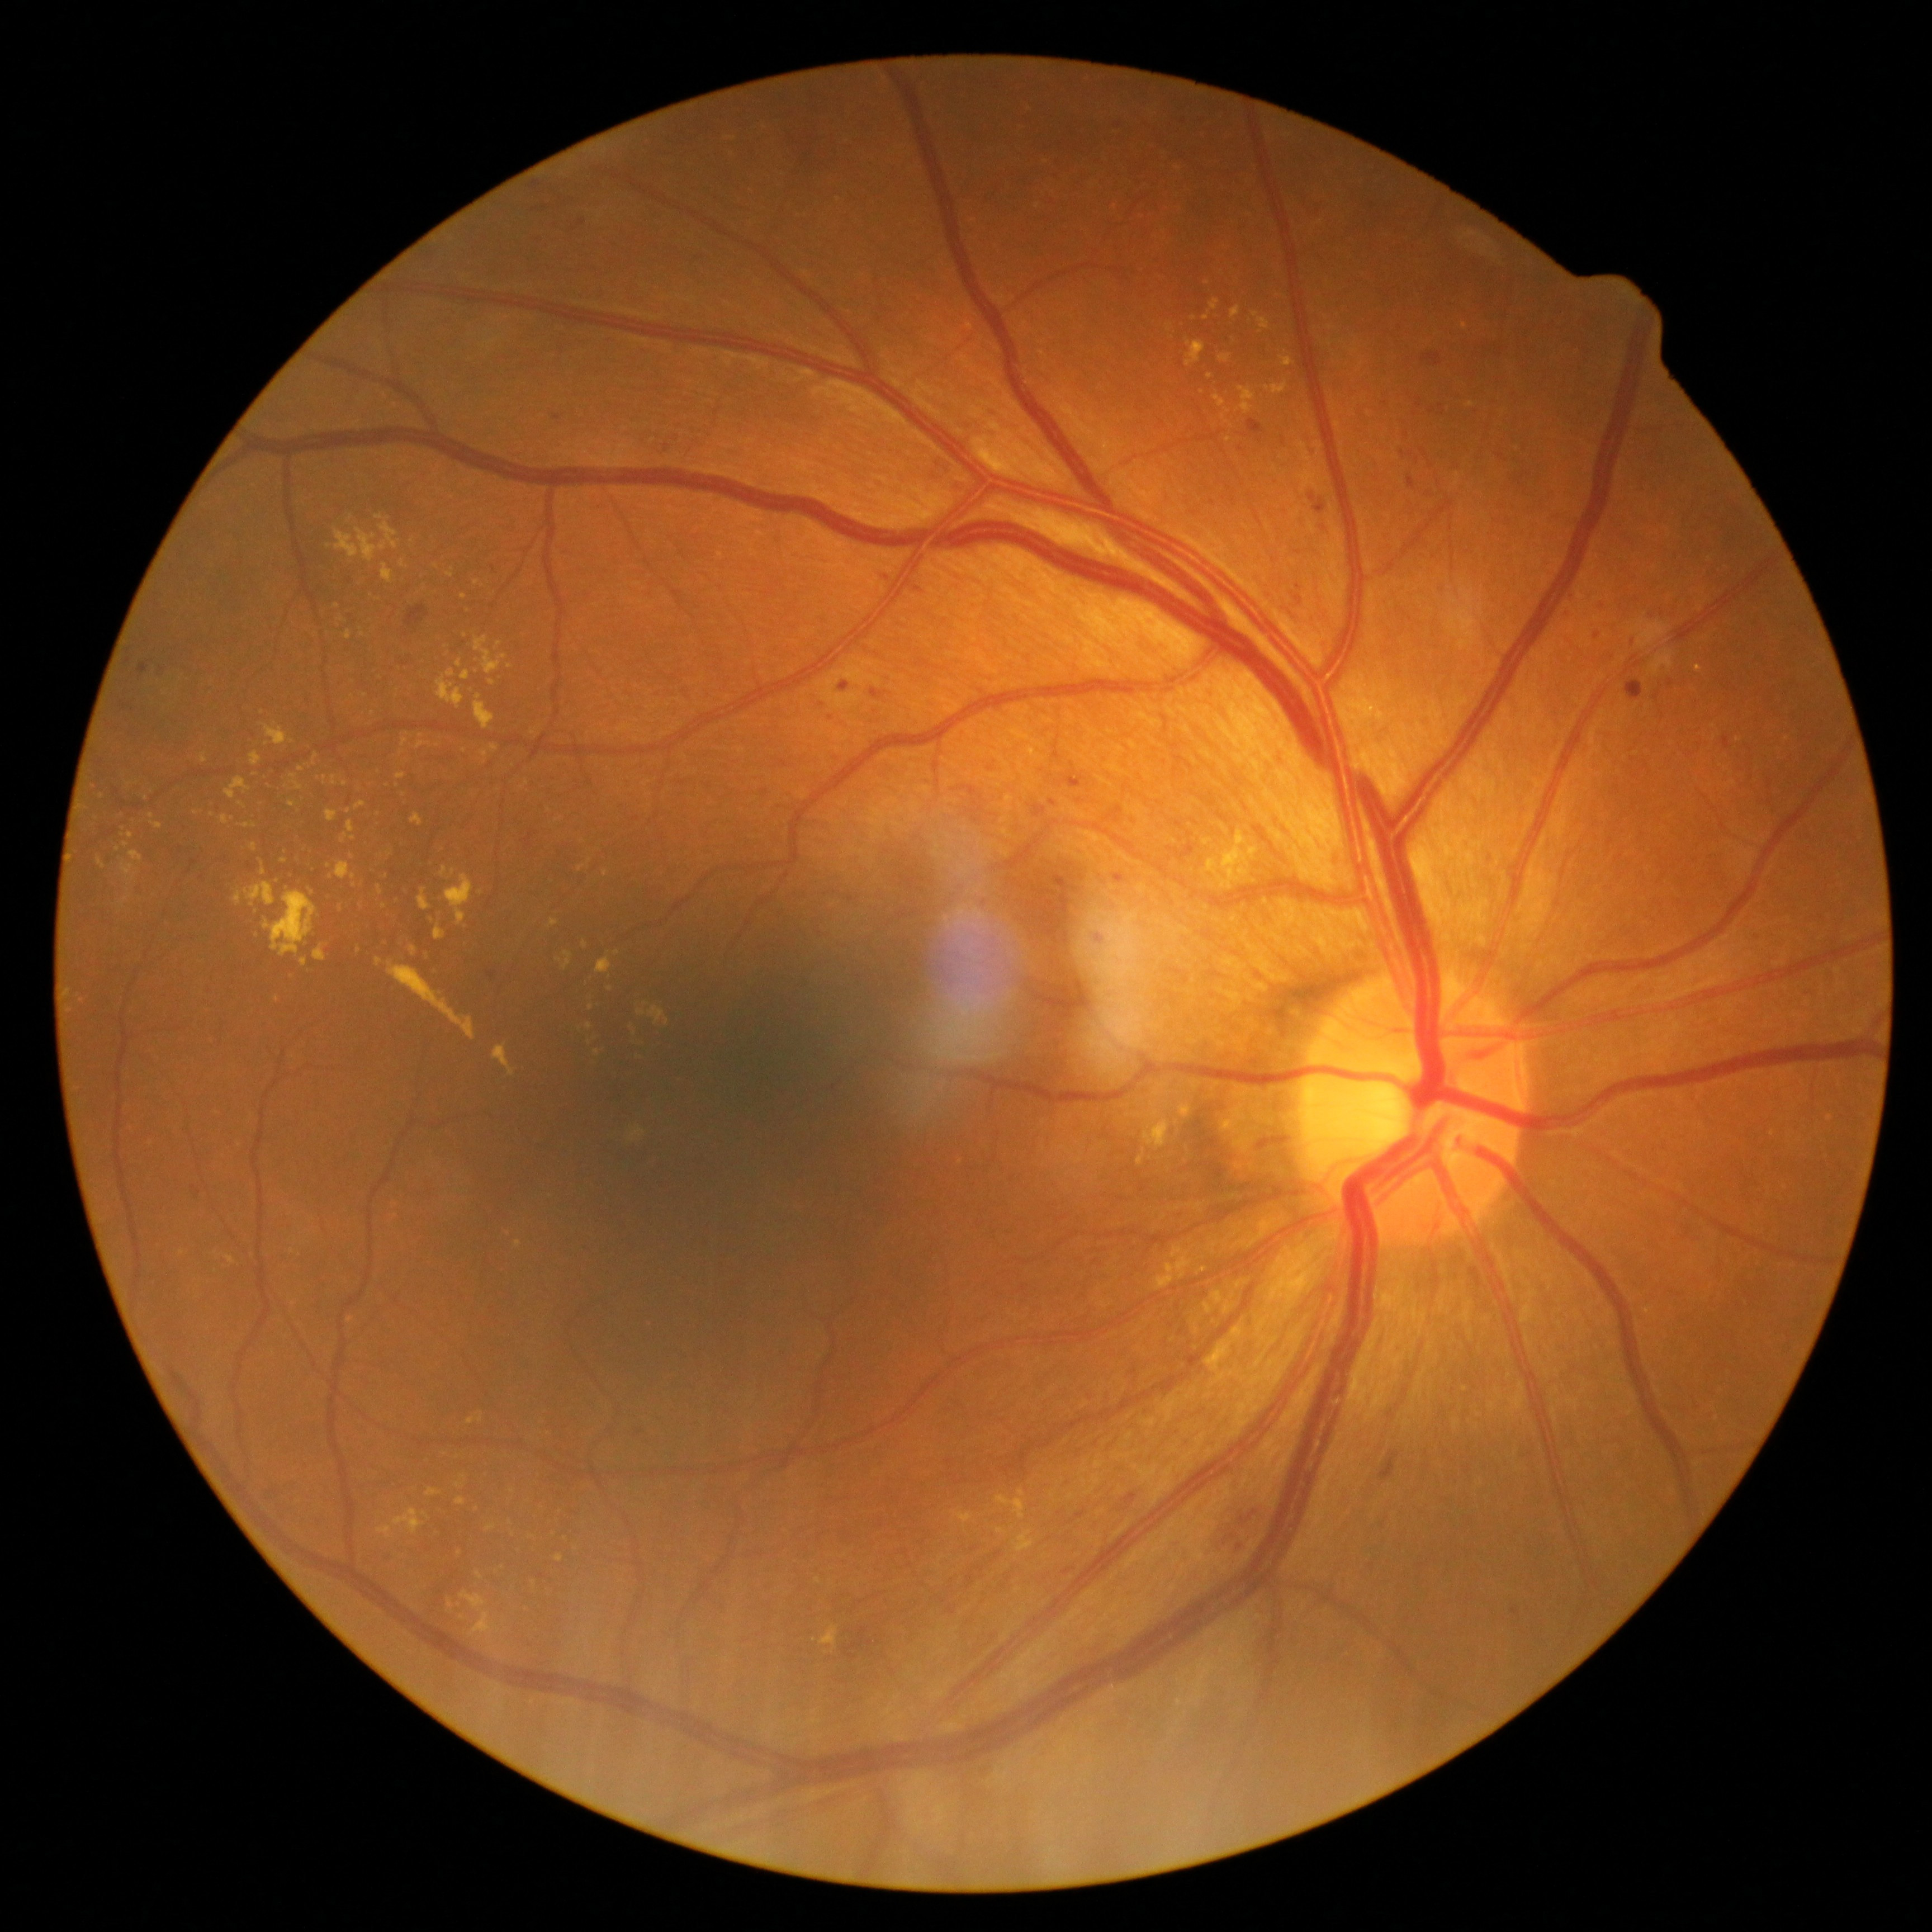

DR: grade 2 (moderate NPDR)
Selected lesions:
MAs (subset): (1168, 842, 1196, 863); (1599, 600, 1603, 609); (870, 688, 885, 698); (1065, 771, 1085, 789); (917, 659, 933, 670); (1097, 932, 1104, 943); (401, 662, 409, 667); (962, 787, 977, 795); (1115, 875, 1124, 882); (488, 970, 498, 981); (1401, 452, 1414, 458); (714, 410, 722, 416); (191, 1186, 202, 1198); (1723, 736, 1730, 750)
MAs (small, approximate centers) near <pt>535,210</pt>; <pt>1597,635</pt>; <pt>583,223</pt>; <pt>700,258</pt>; <pt>1631,640</pt>; <pt>1313,497</pt>
HEs: (1124, 1493, 1137, 1502); (1221, 1488, 1248, 1552); (1420, 354, 1443, 366); (1379, 1450, 1399, 1481); (965, 1567, 986, 1588); (1626, 680, 1644, 700); (1268, 1139, 1290, 1144); (405, 605, 430, 632); (844, 1626, 874, 1660)
SEs: none
EXs (subset): (340, 834, 347, 845); (376, 958, 383, 967); (649, 1006, 666, 1024); (326, 810, 338, 822); (355, 801, 367, 810); (953, 1513, 973, 1523); (1210, 300, 1219, 310); (308, 887, 315, 895); (387, 961, 477, 1040); (475, 636, 507, 676); (225, 778, 250, 800)
EXs (small, approximate centers) near <pt>549,810</pt>; <pt>348,811</pt>; <pt>344,784</pt>; <pt>337,607</pt>; <pt>350,519</pt>; <pt>513,1491</pt>; <pt>354,838</pt>; <pt>1210,375</pt>; <pt>284,861</pt>